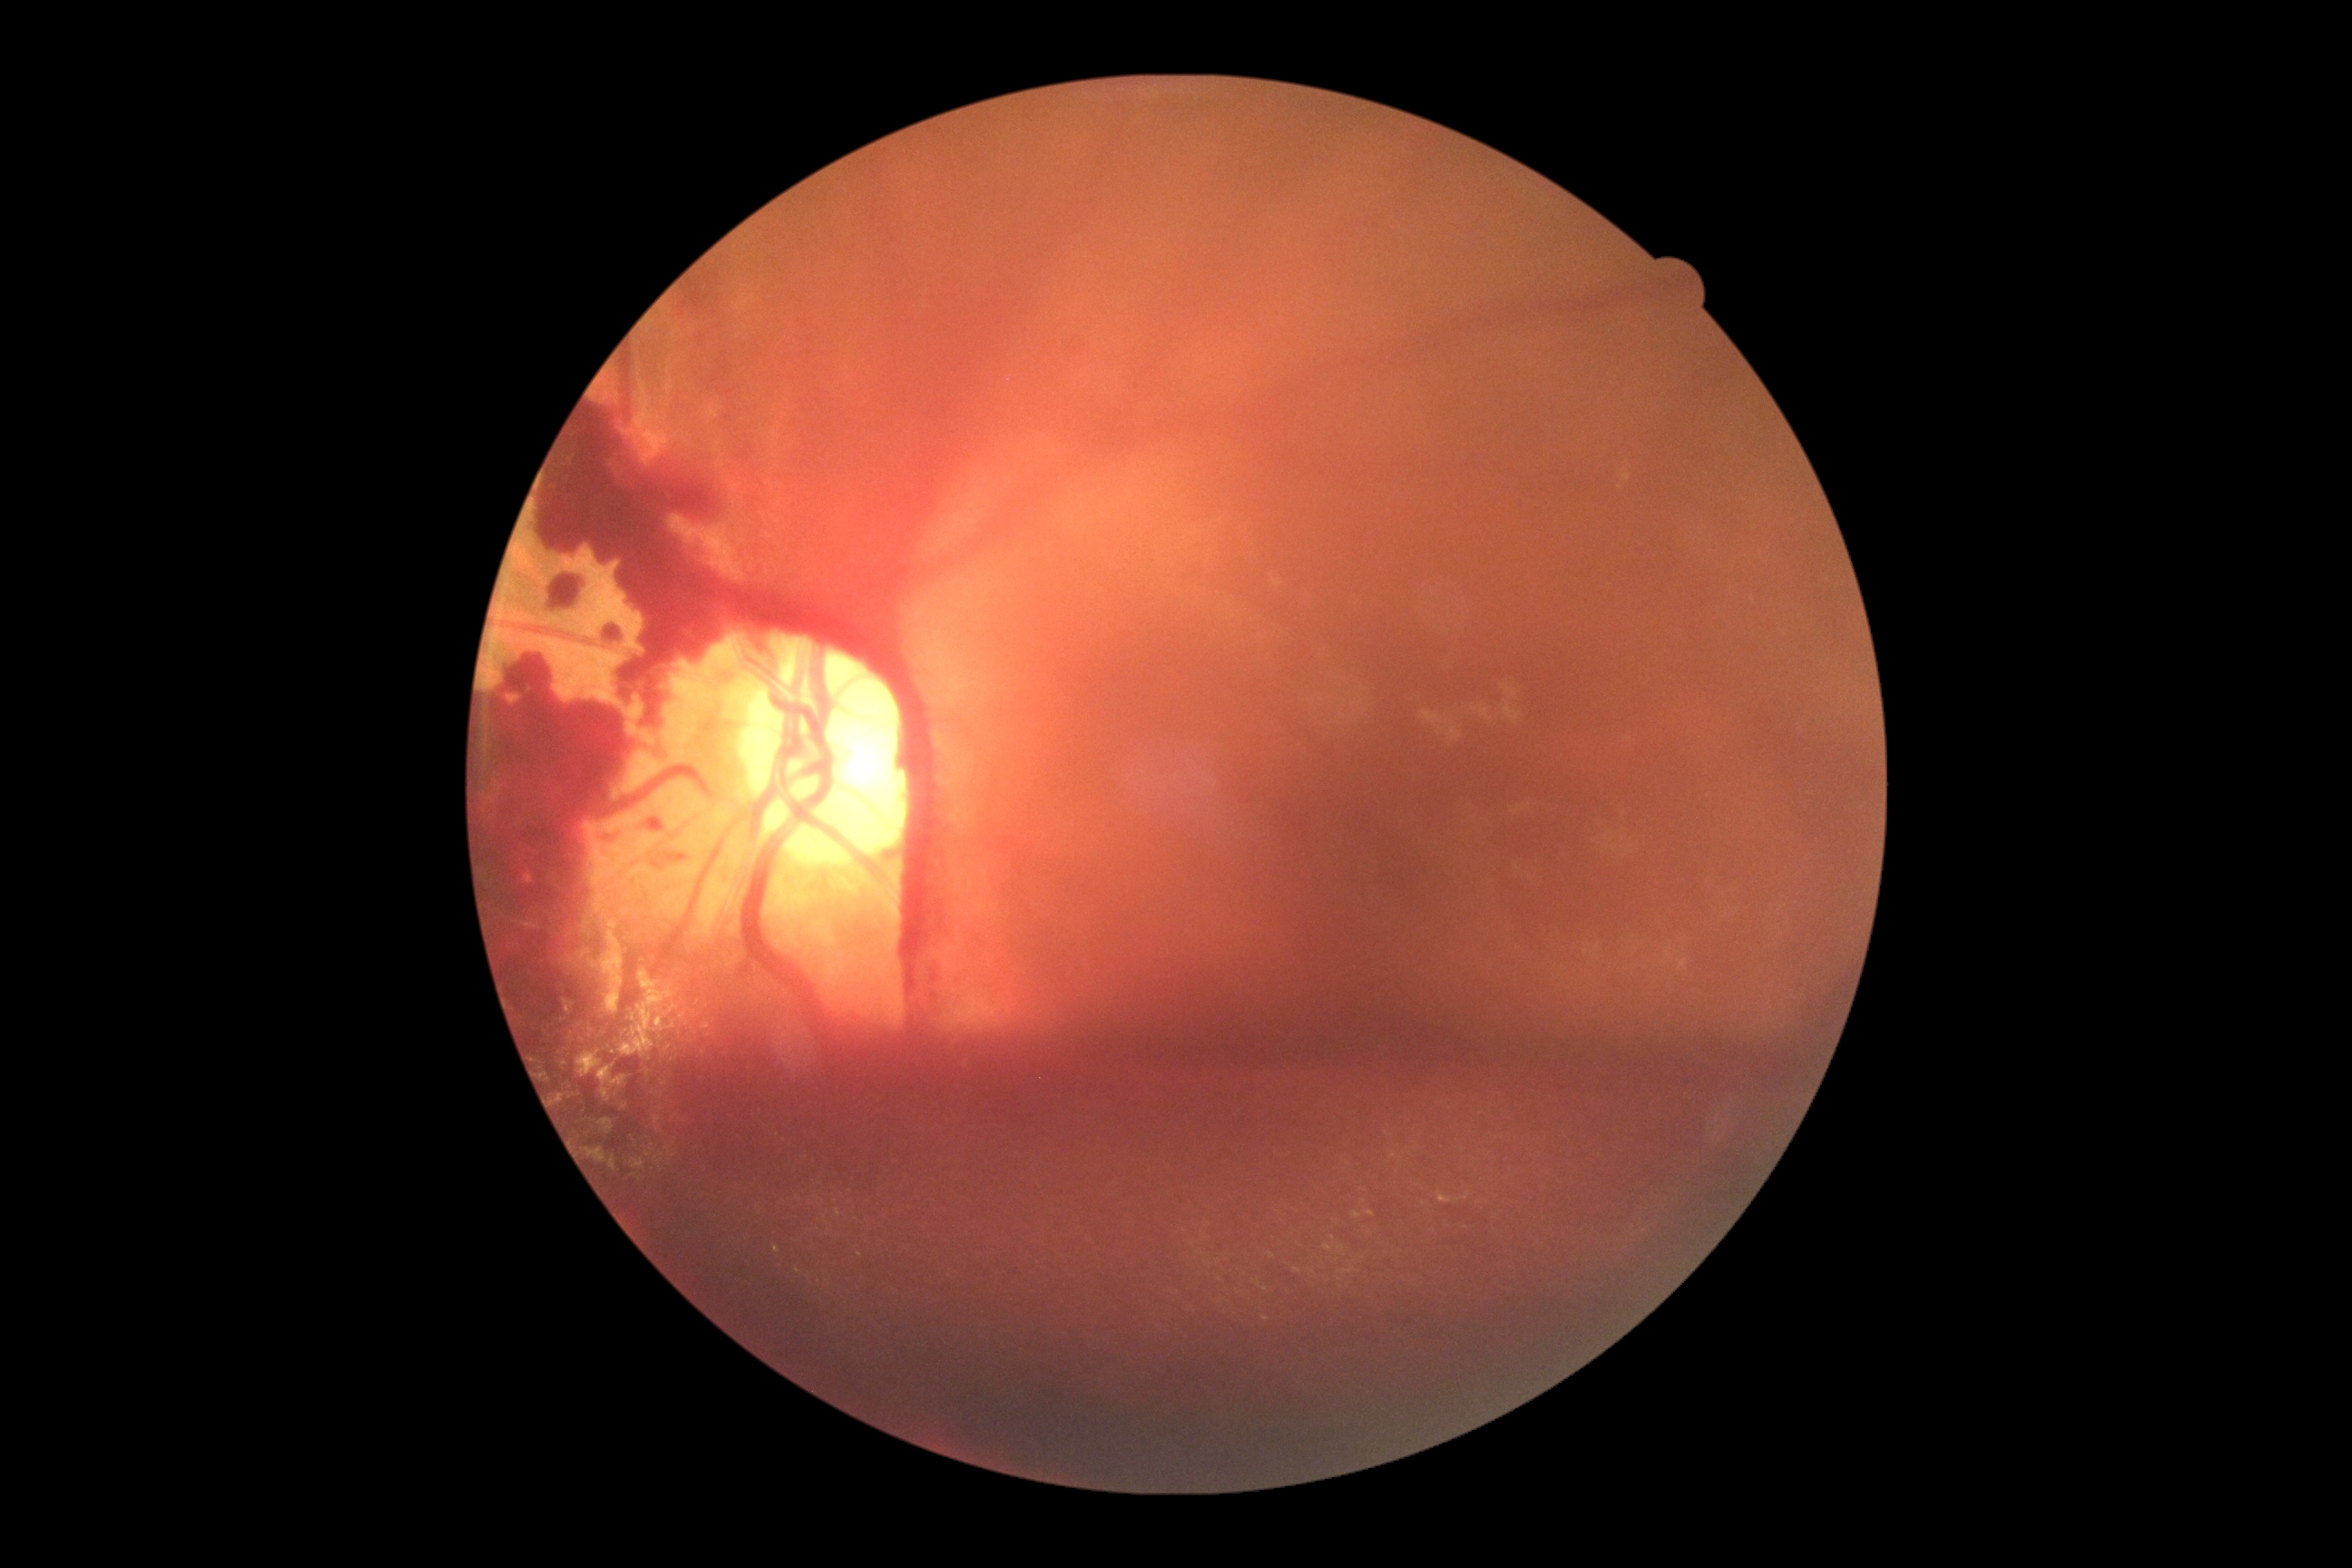
DR class: proliferative diabetic retinopathy
DR severity: grade 4 (PDR)